Clarity RetCam 3, 130° FOV; RetCam wide-field infant fundus image.
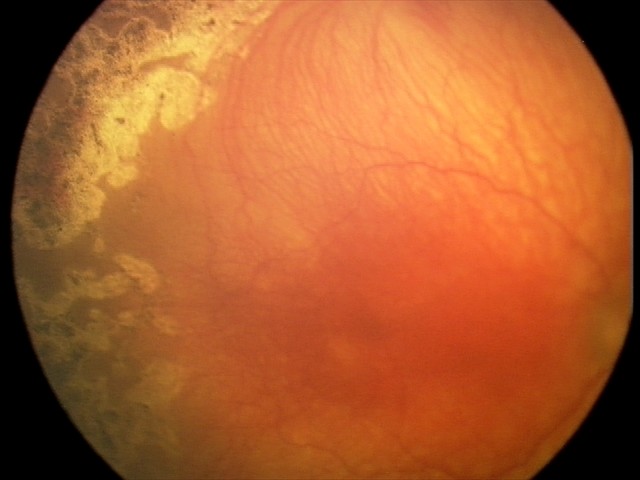

Screening diagnosis: A-ROP (aggressive ROP).